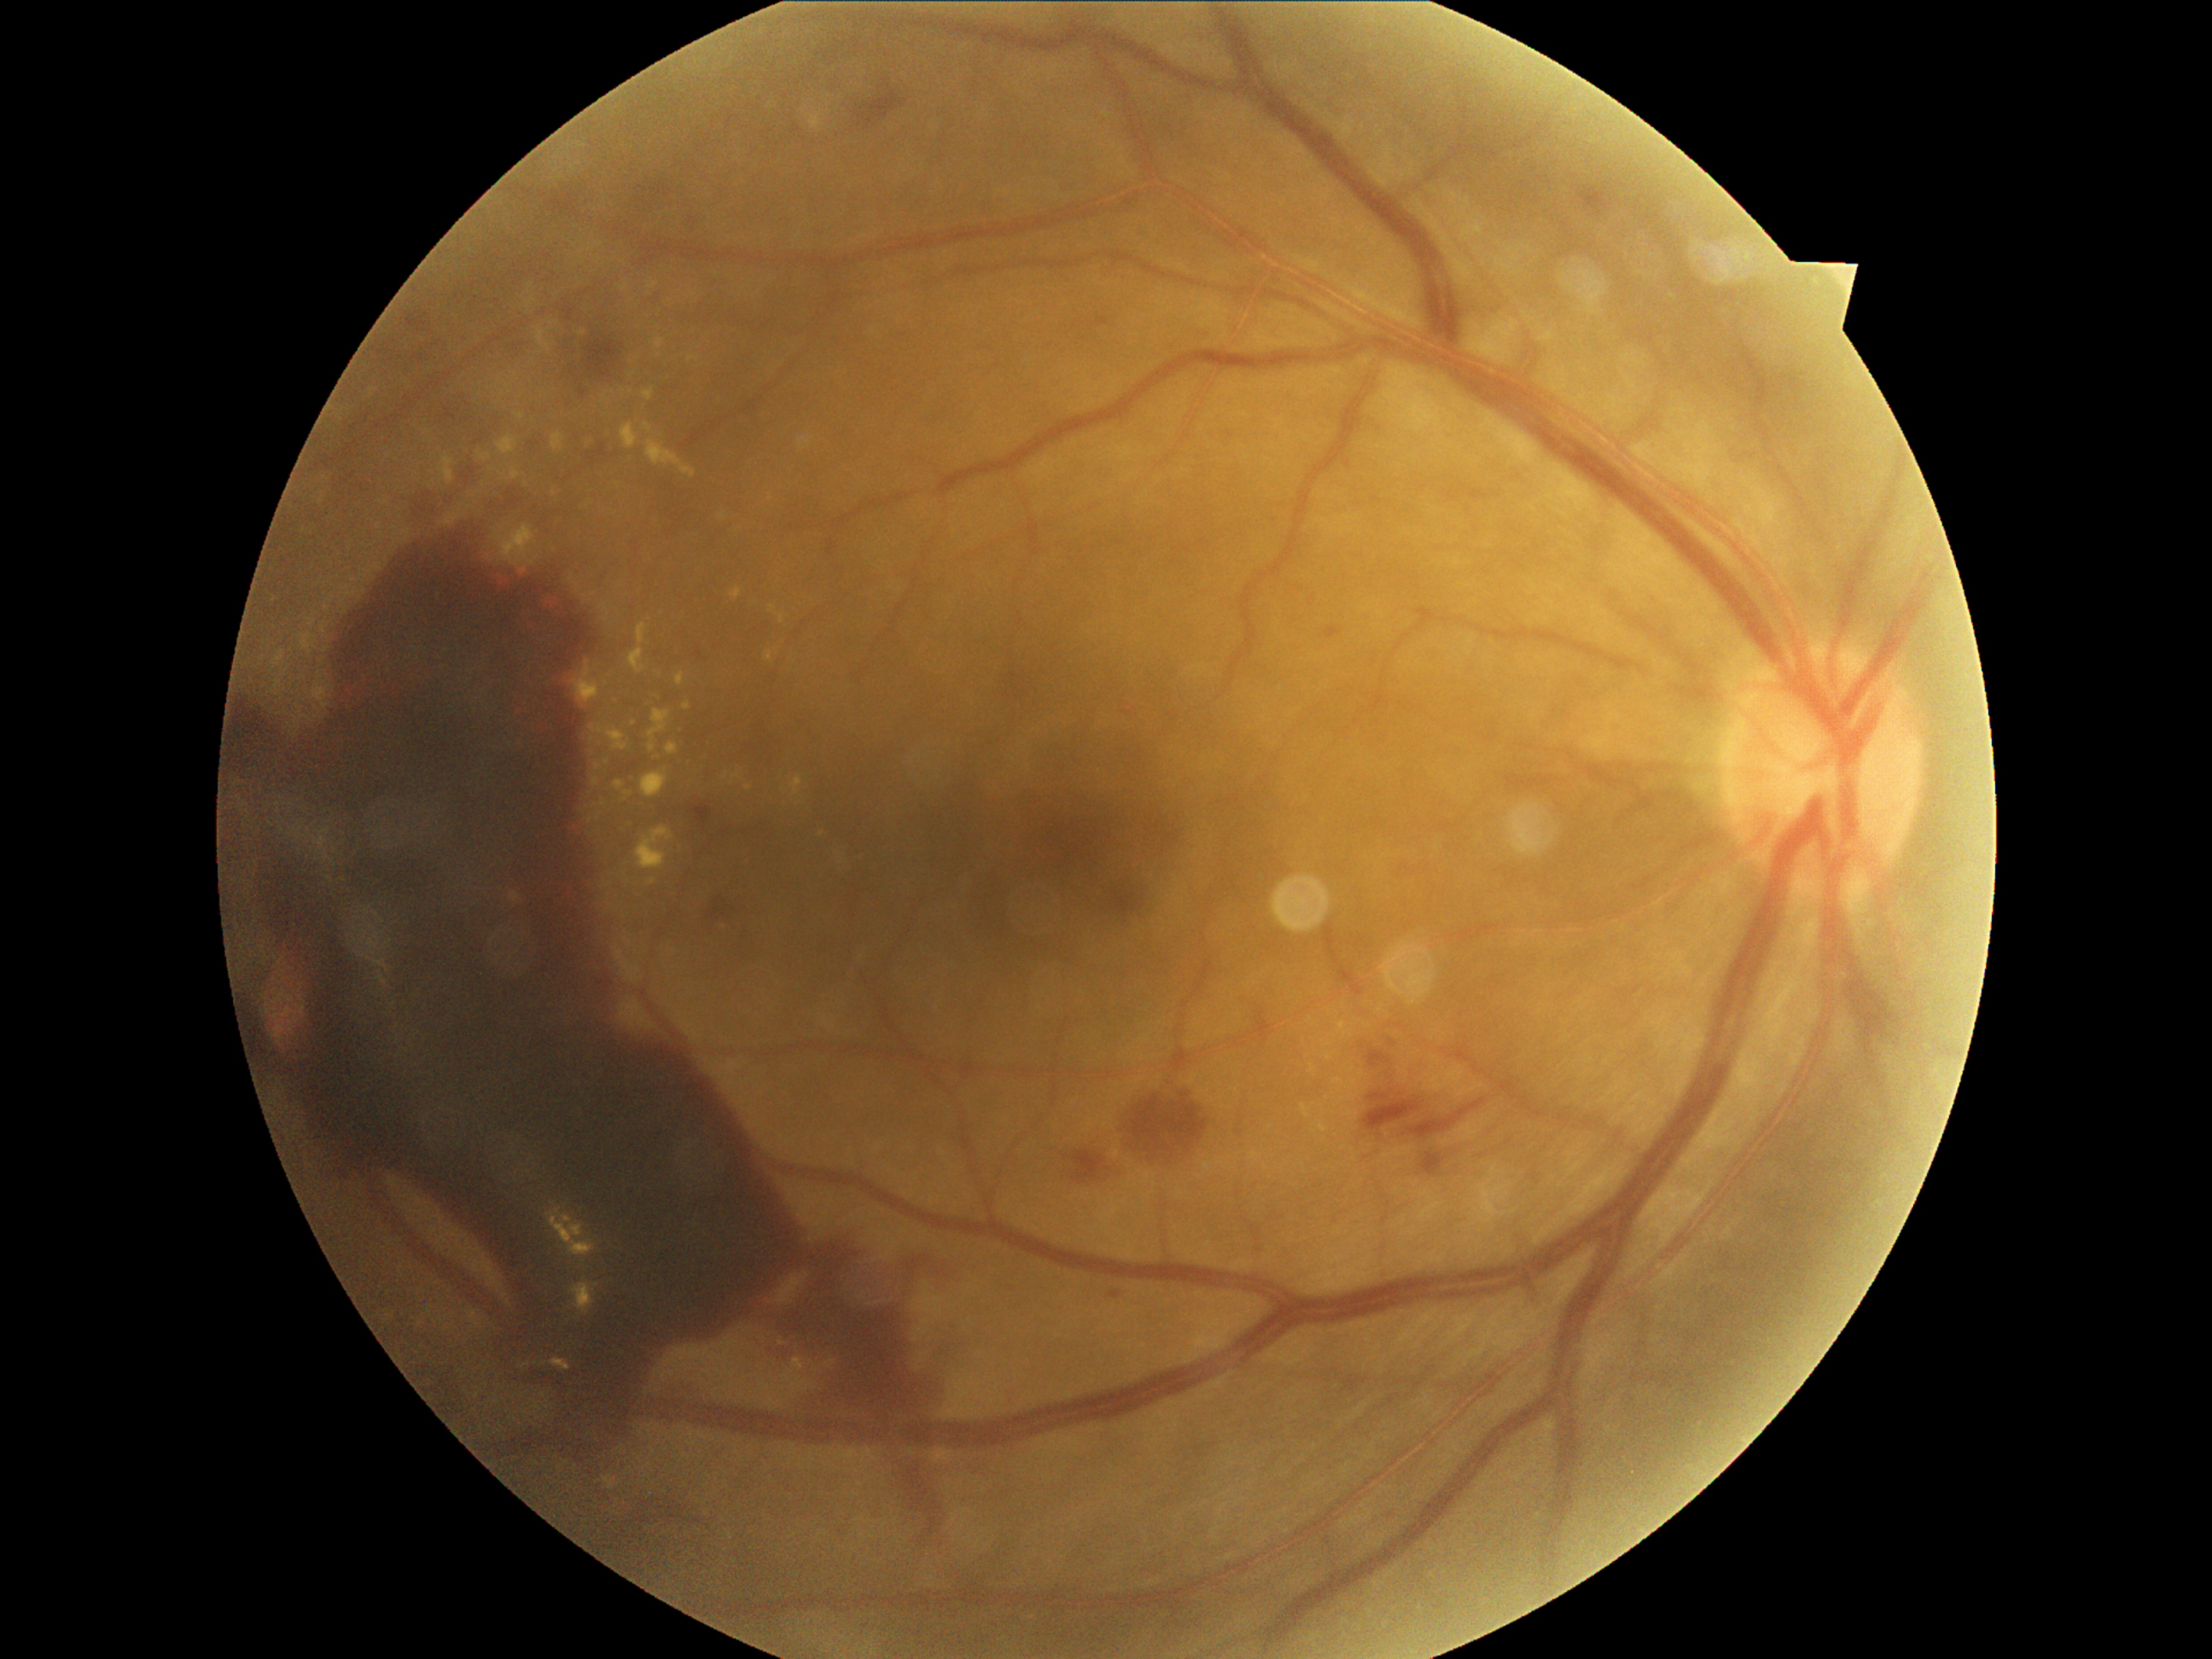 Diabetic retinopathy severity: grade 4 (PDR).